Pediatric retinal photograph (wide-field). Image size 1440x1080.
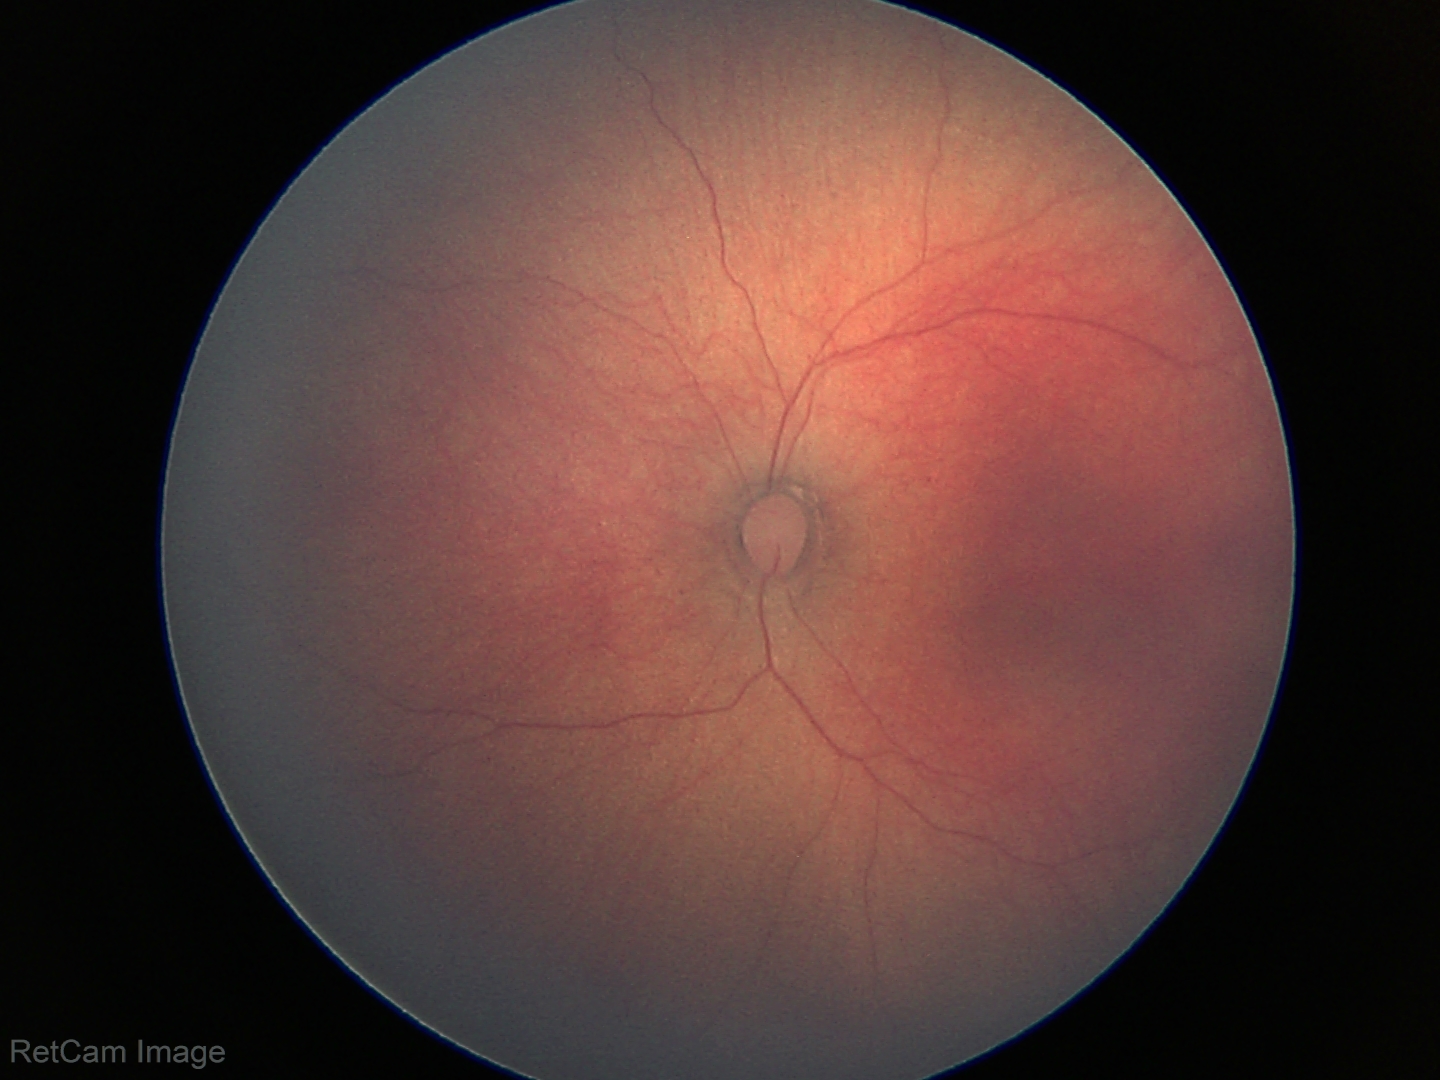 Q: What is the screening diagnosis?
A: physiological finding